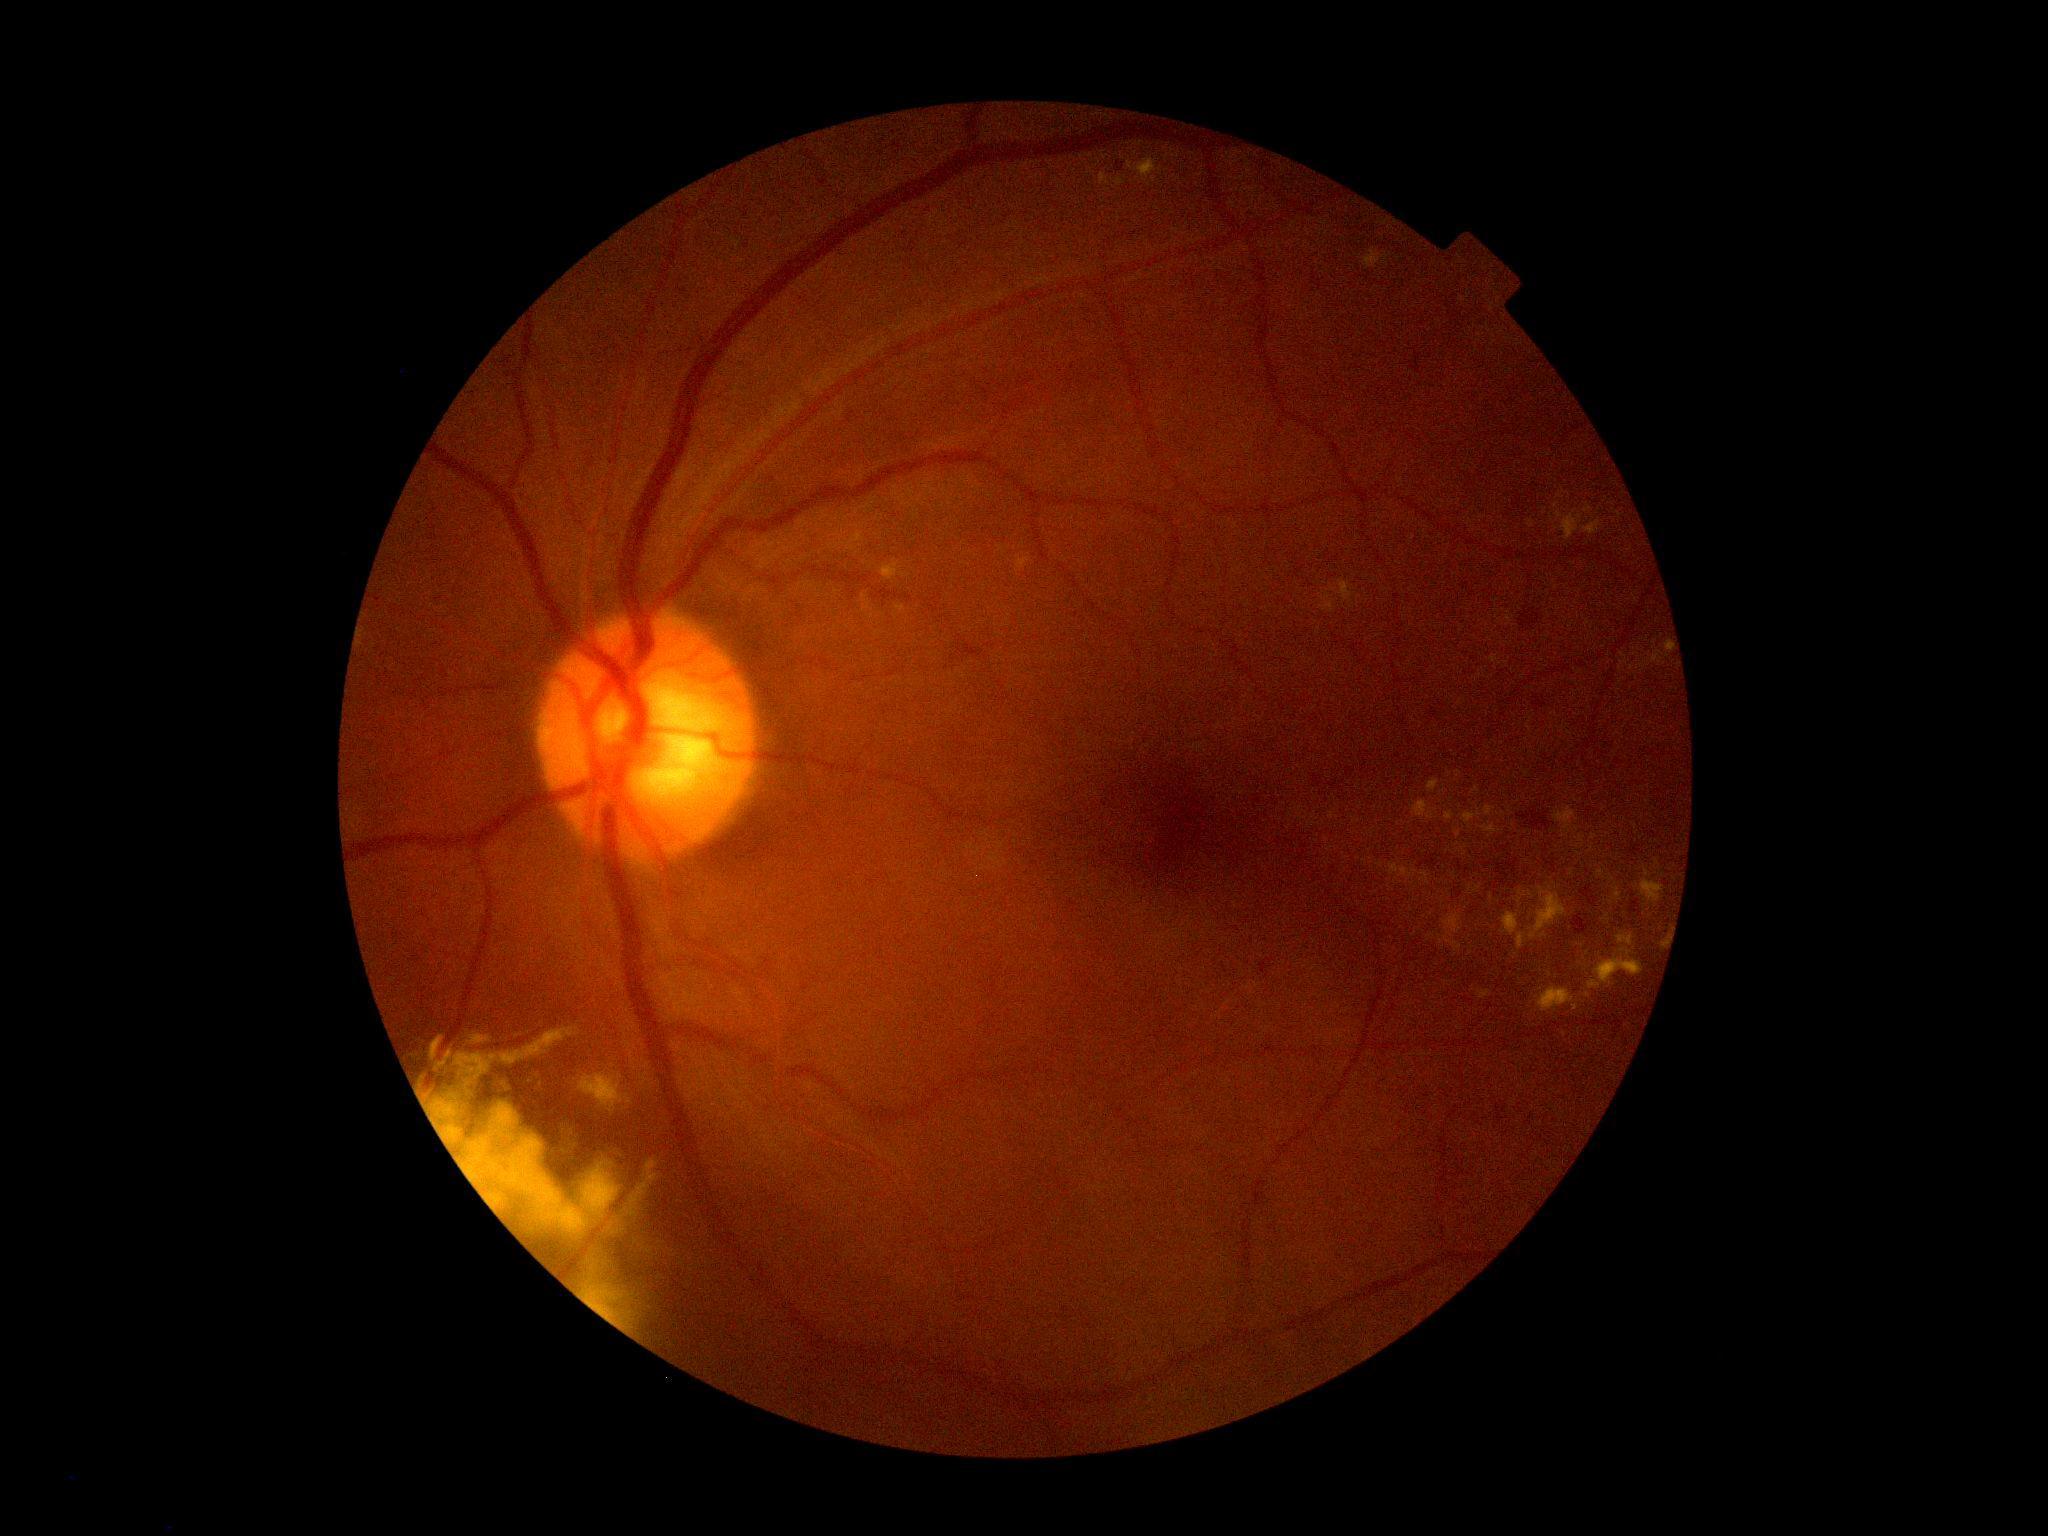 Diabetic retinopathy (DR): 2; non-proliferative diabetic retinopathy
Lesions identified (partial list):
hard exudates (EXs) (subset): 1603/914/1611/921; 1666/641/1673/658; 1641/867/1665/904; 1554/807/1579/834; 1617/934/1634/946; 1412/801/1435/821; 1477/990/1493/1000; 1462/809/1481/825; 580/1073/633/1114
Additional small EXs near (1435, 811); (1431, 914); (1576, 1008); (1611, 878); (1564, 835); (1431, 937); (1526, 833)